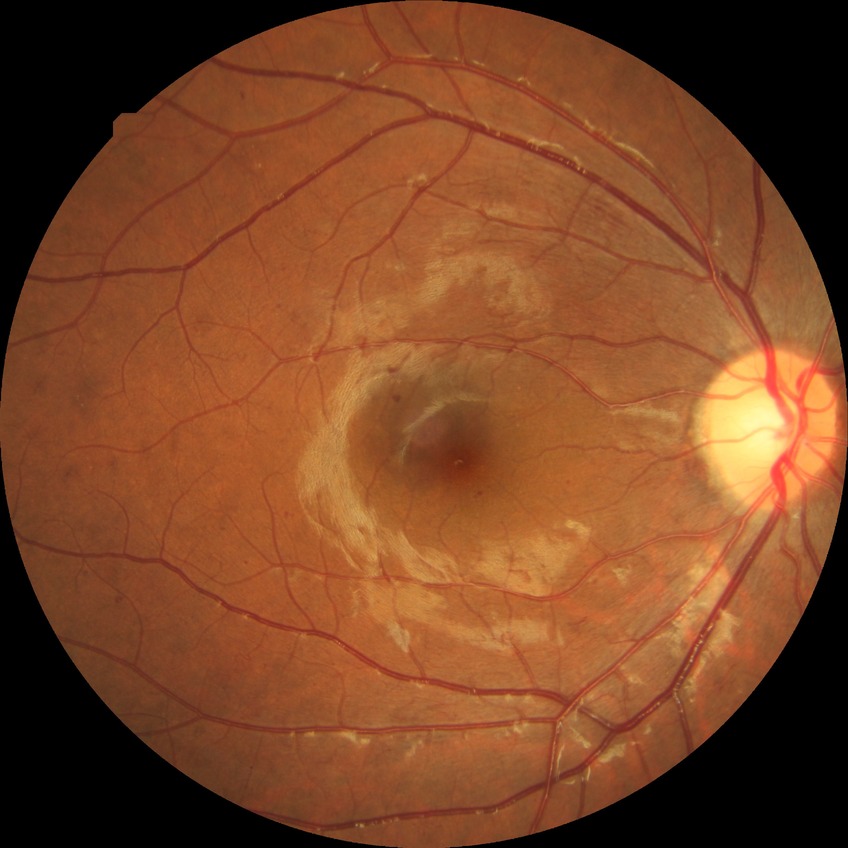 modified Davis classification@pre-proliferative diabetic retinopathy.